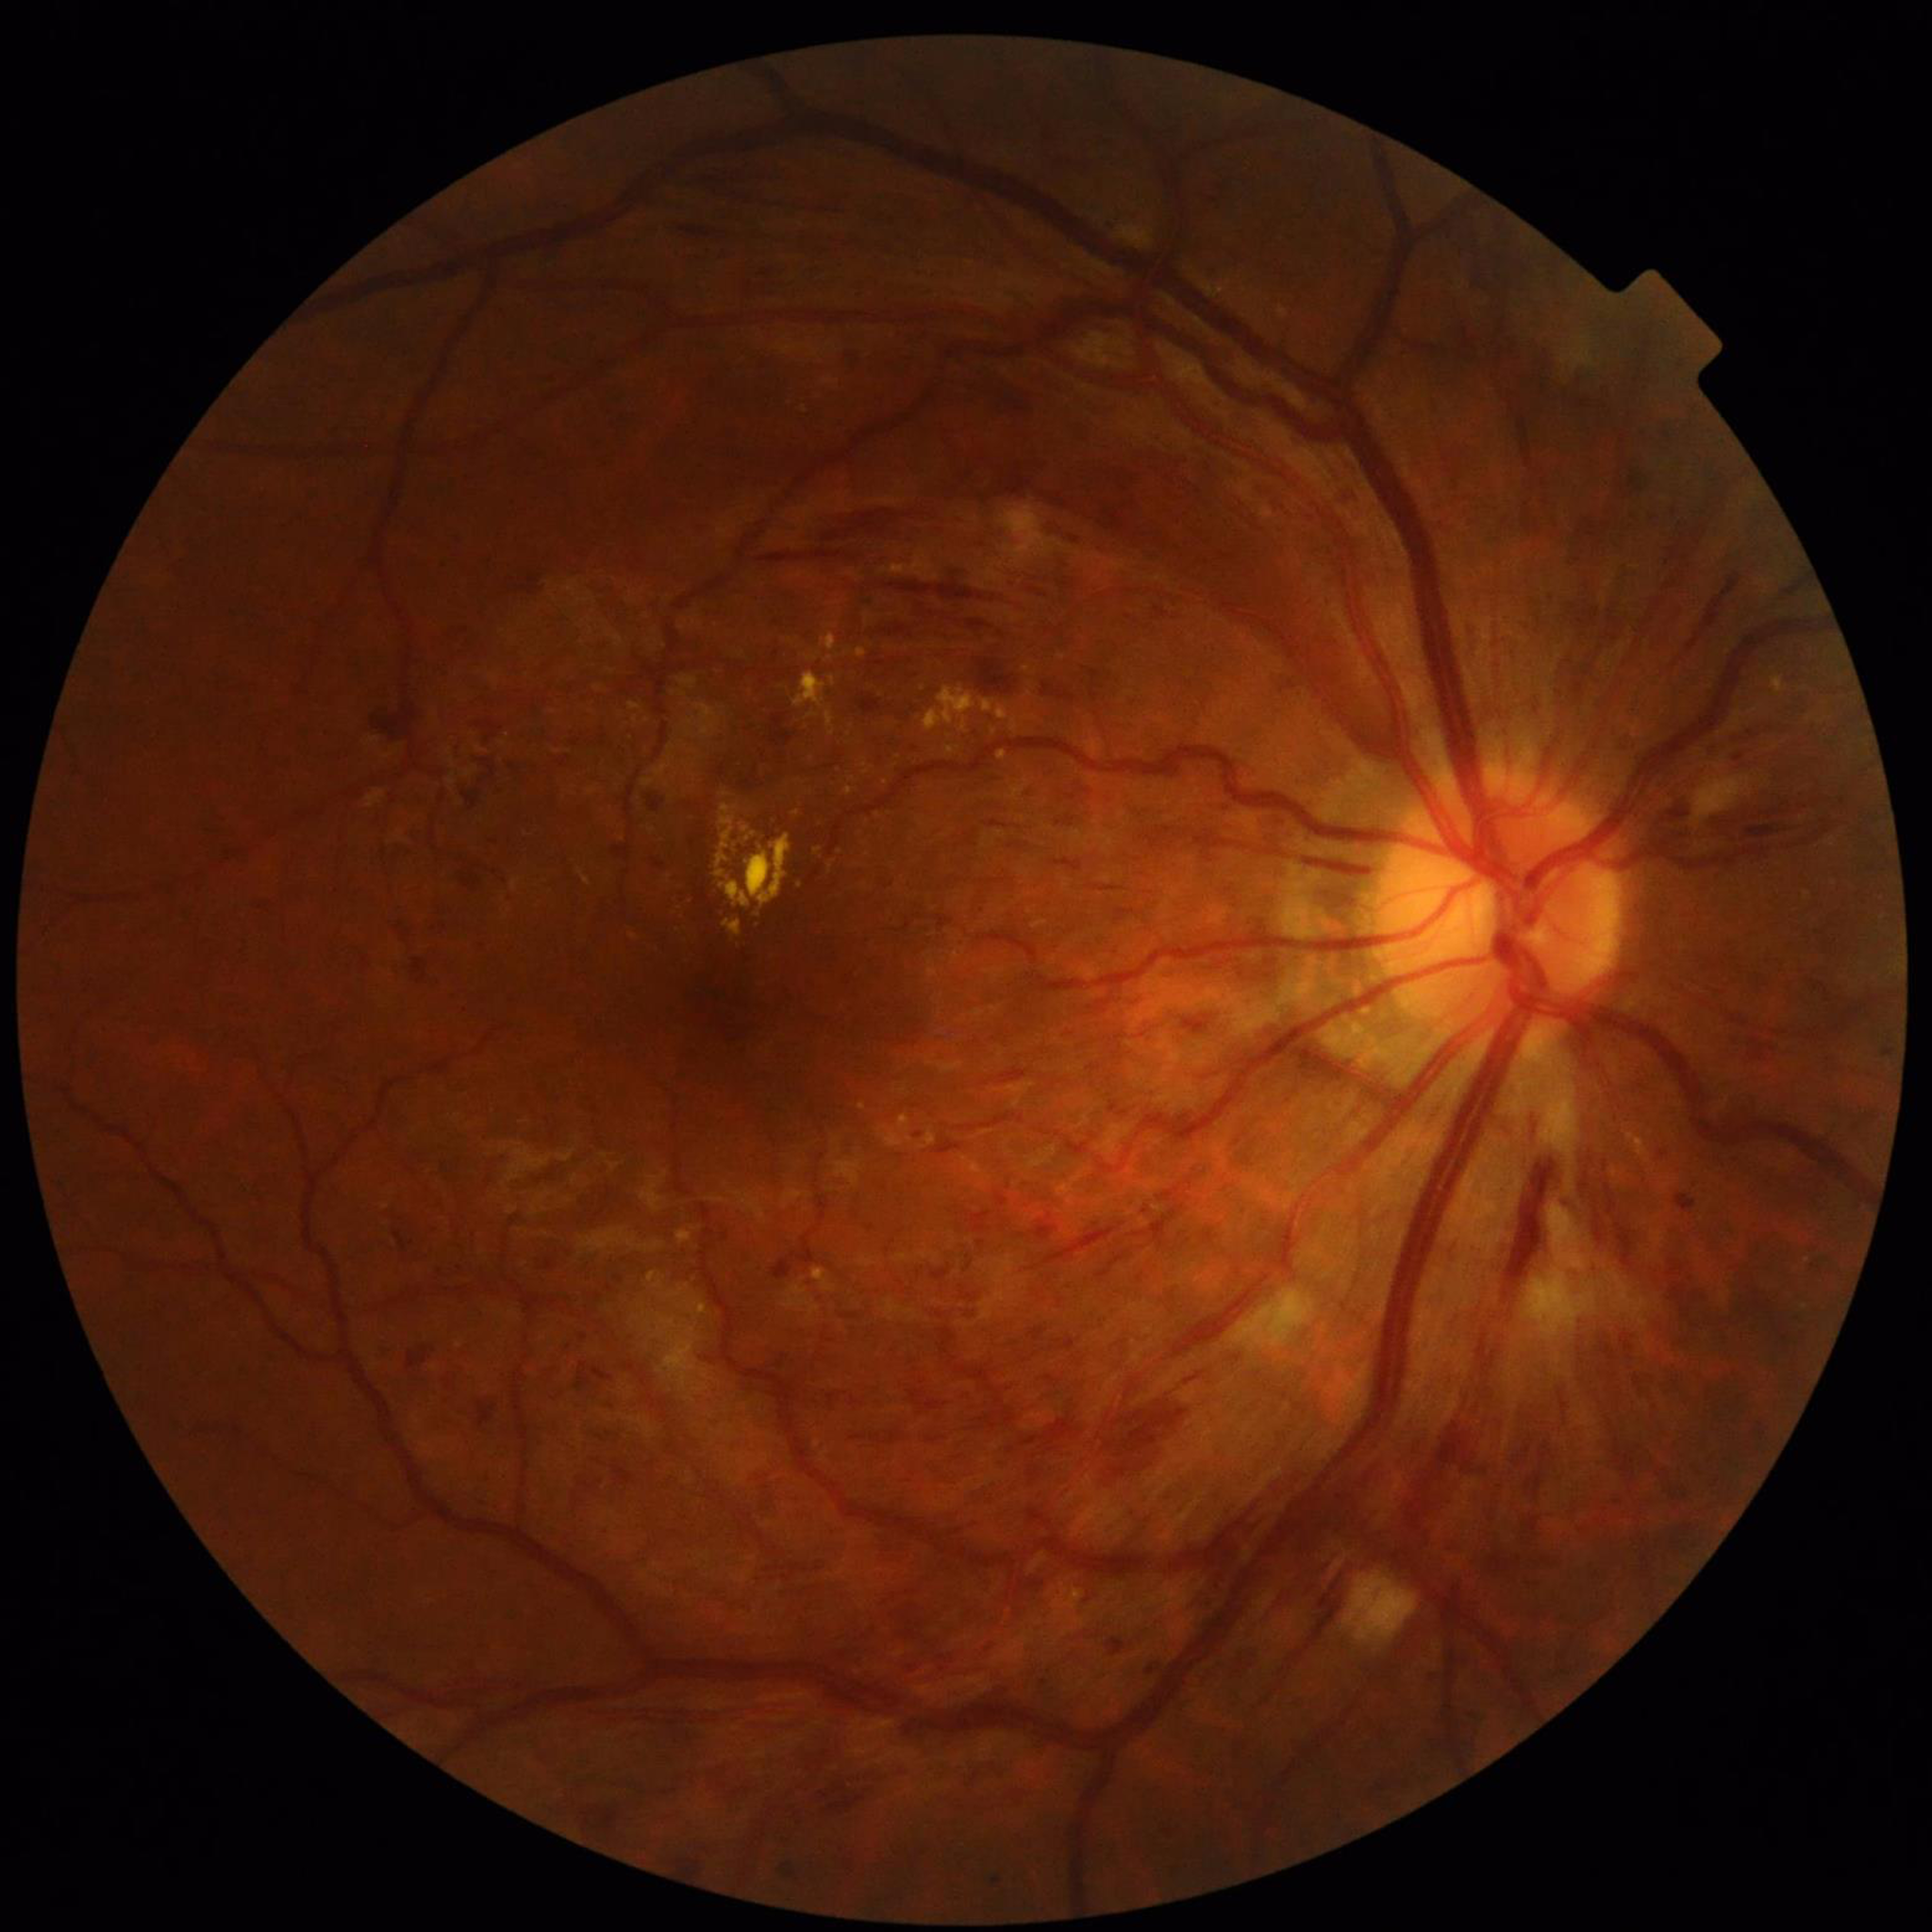

Photo quality: adequate. Fundus image of an eye with diabetic retinopathy (DR).